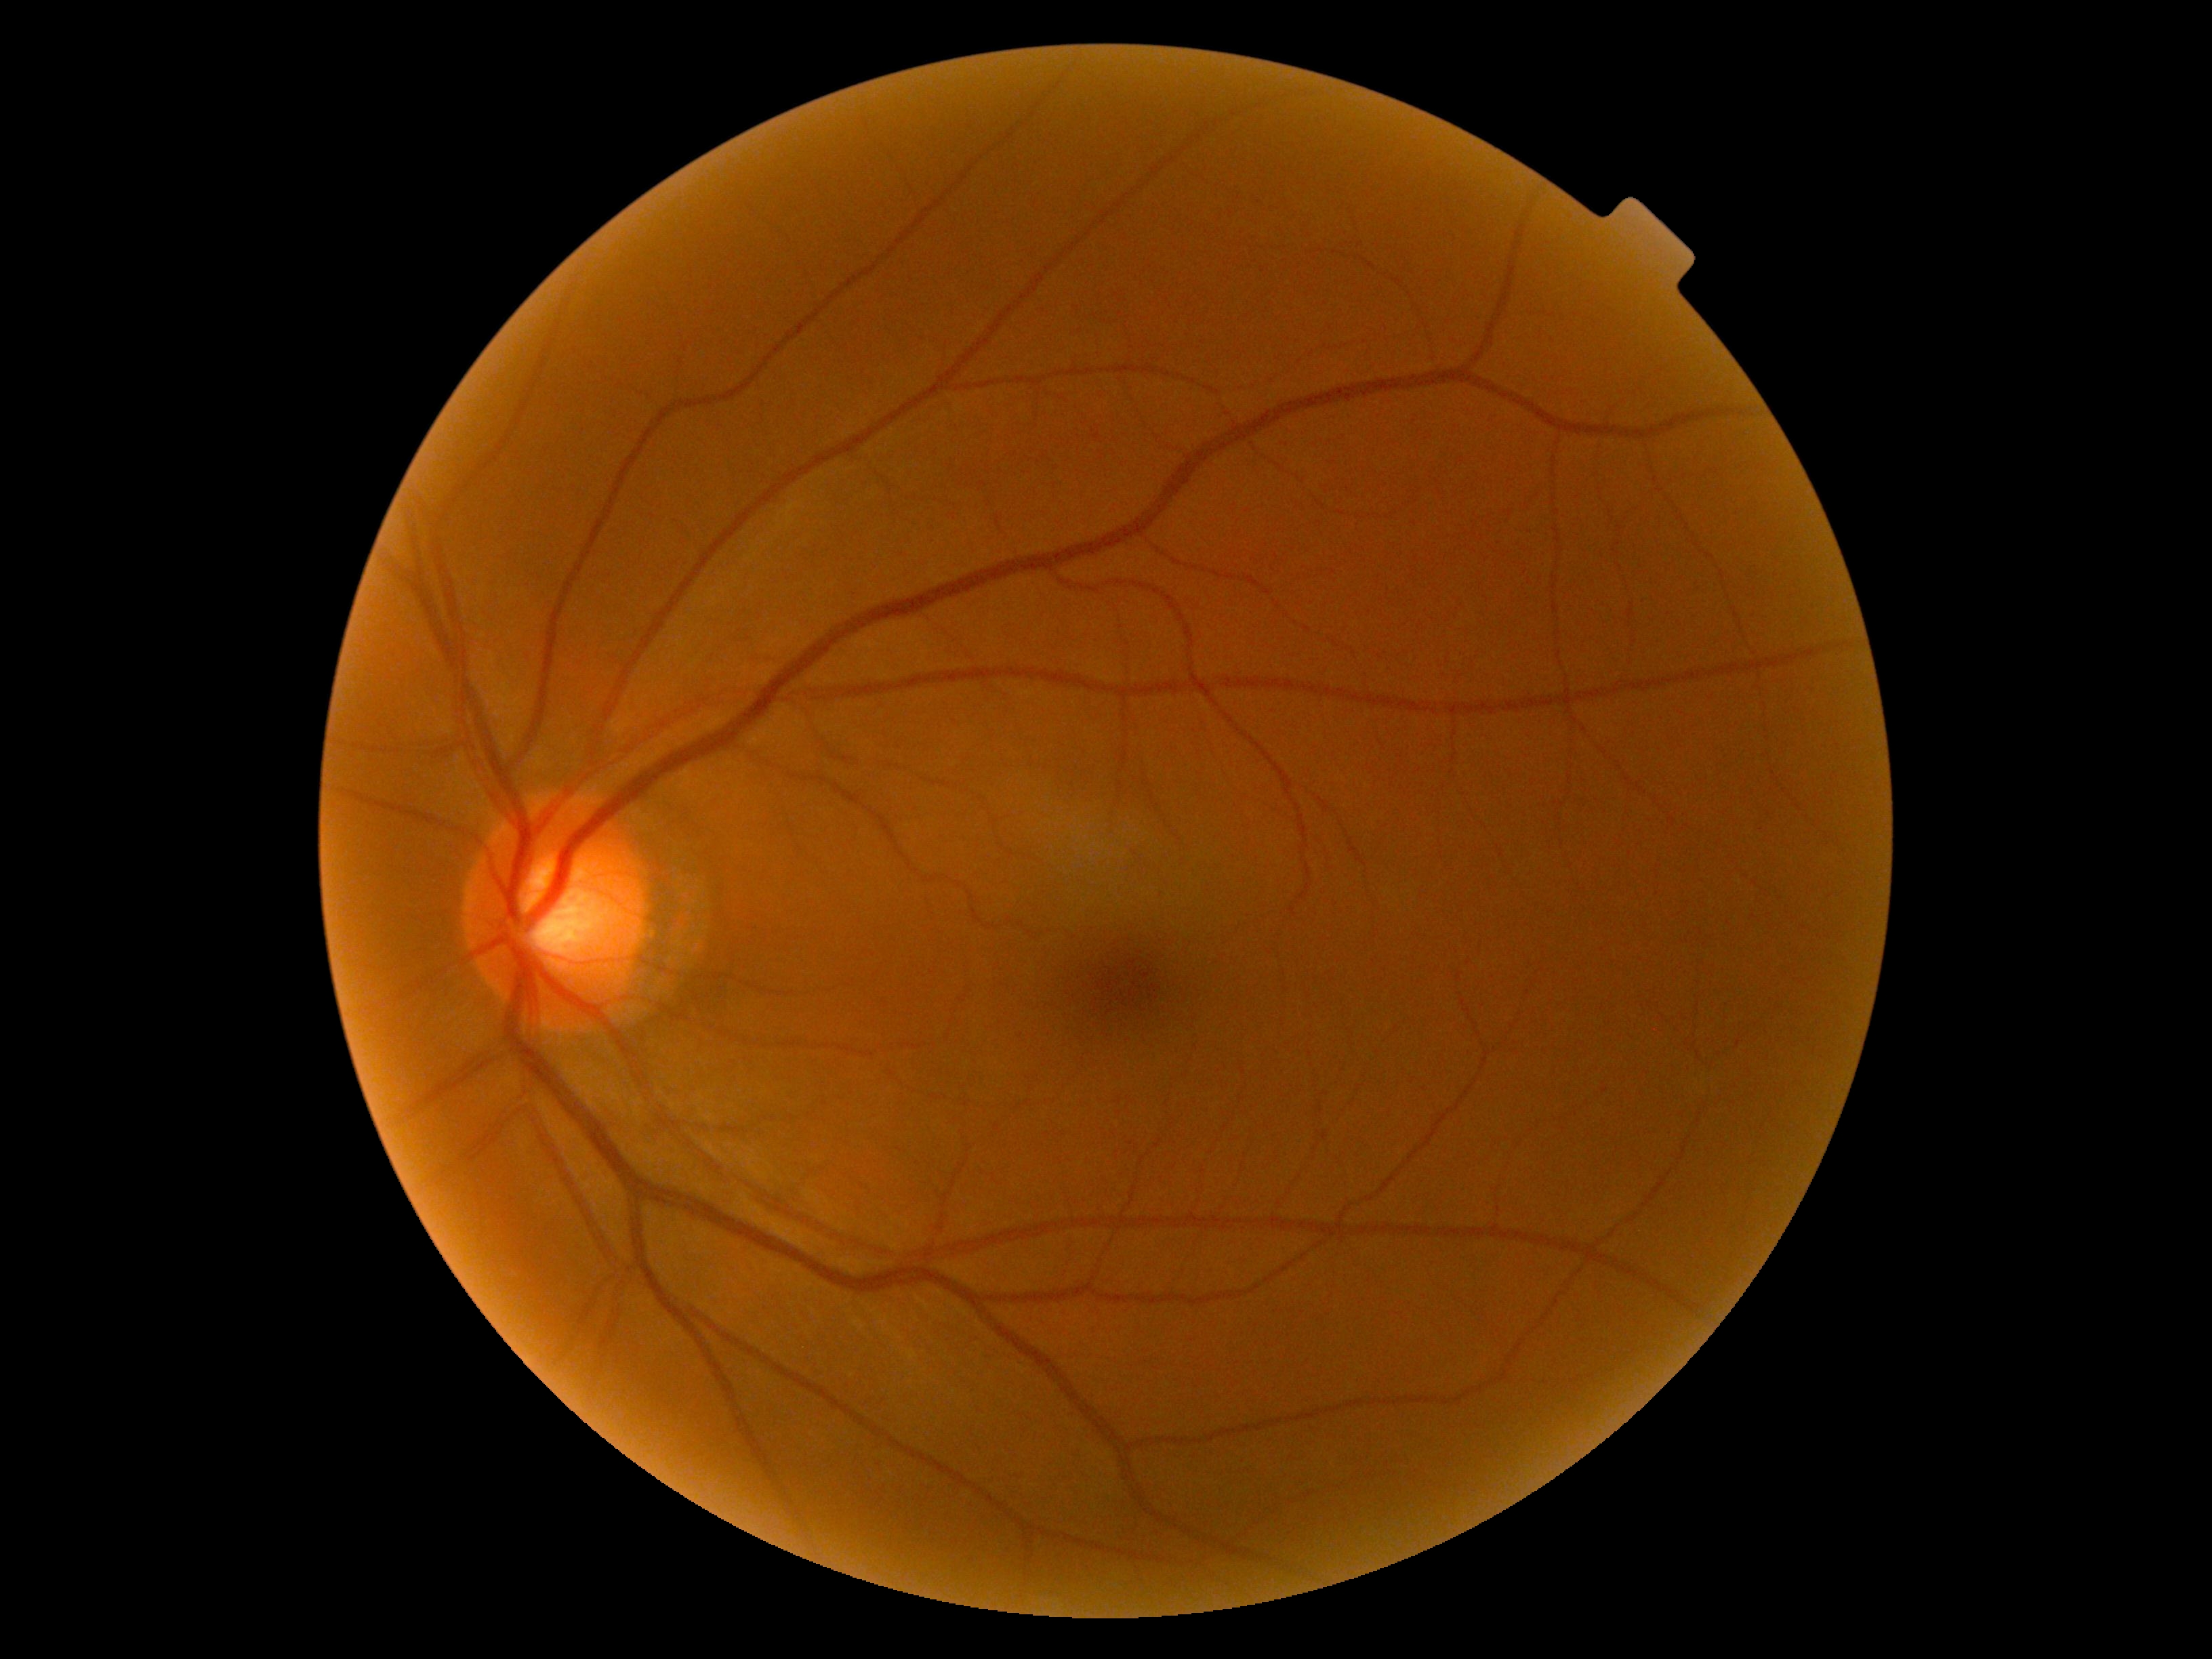

diabetic retinopathy (DR): grade 0 (no apparent retinopathy), DR impression: no DR findings.